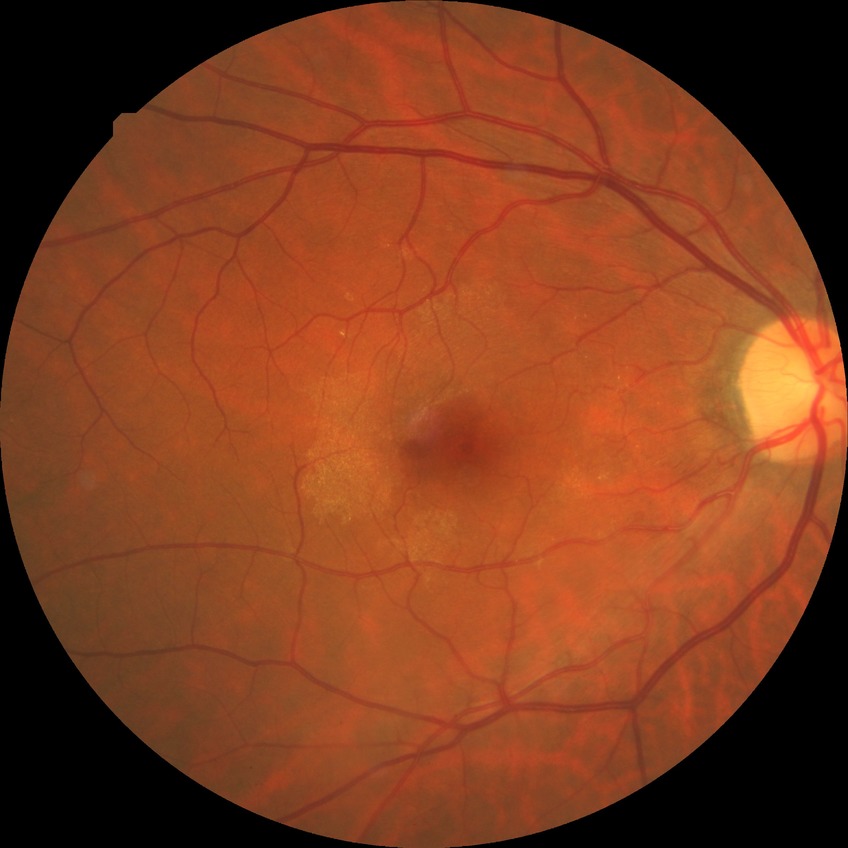 davis_grade: no diabetic retinopathy (NDR)